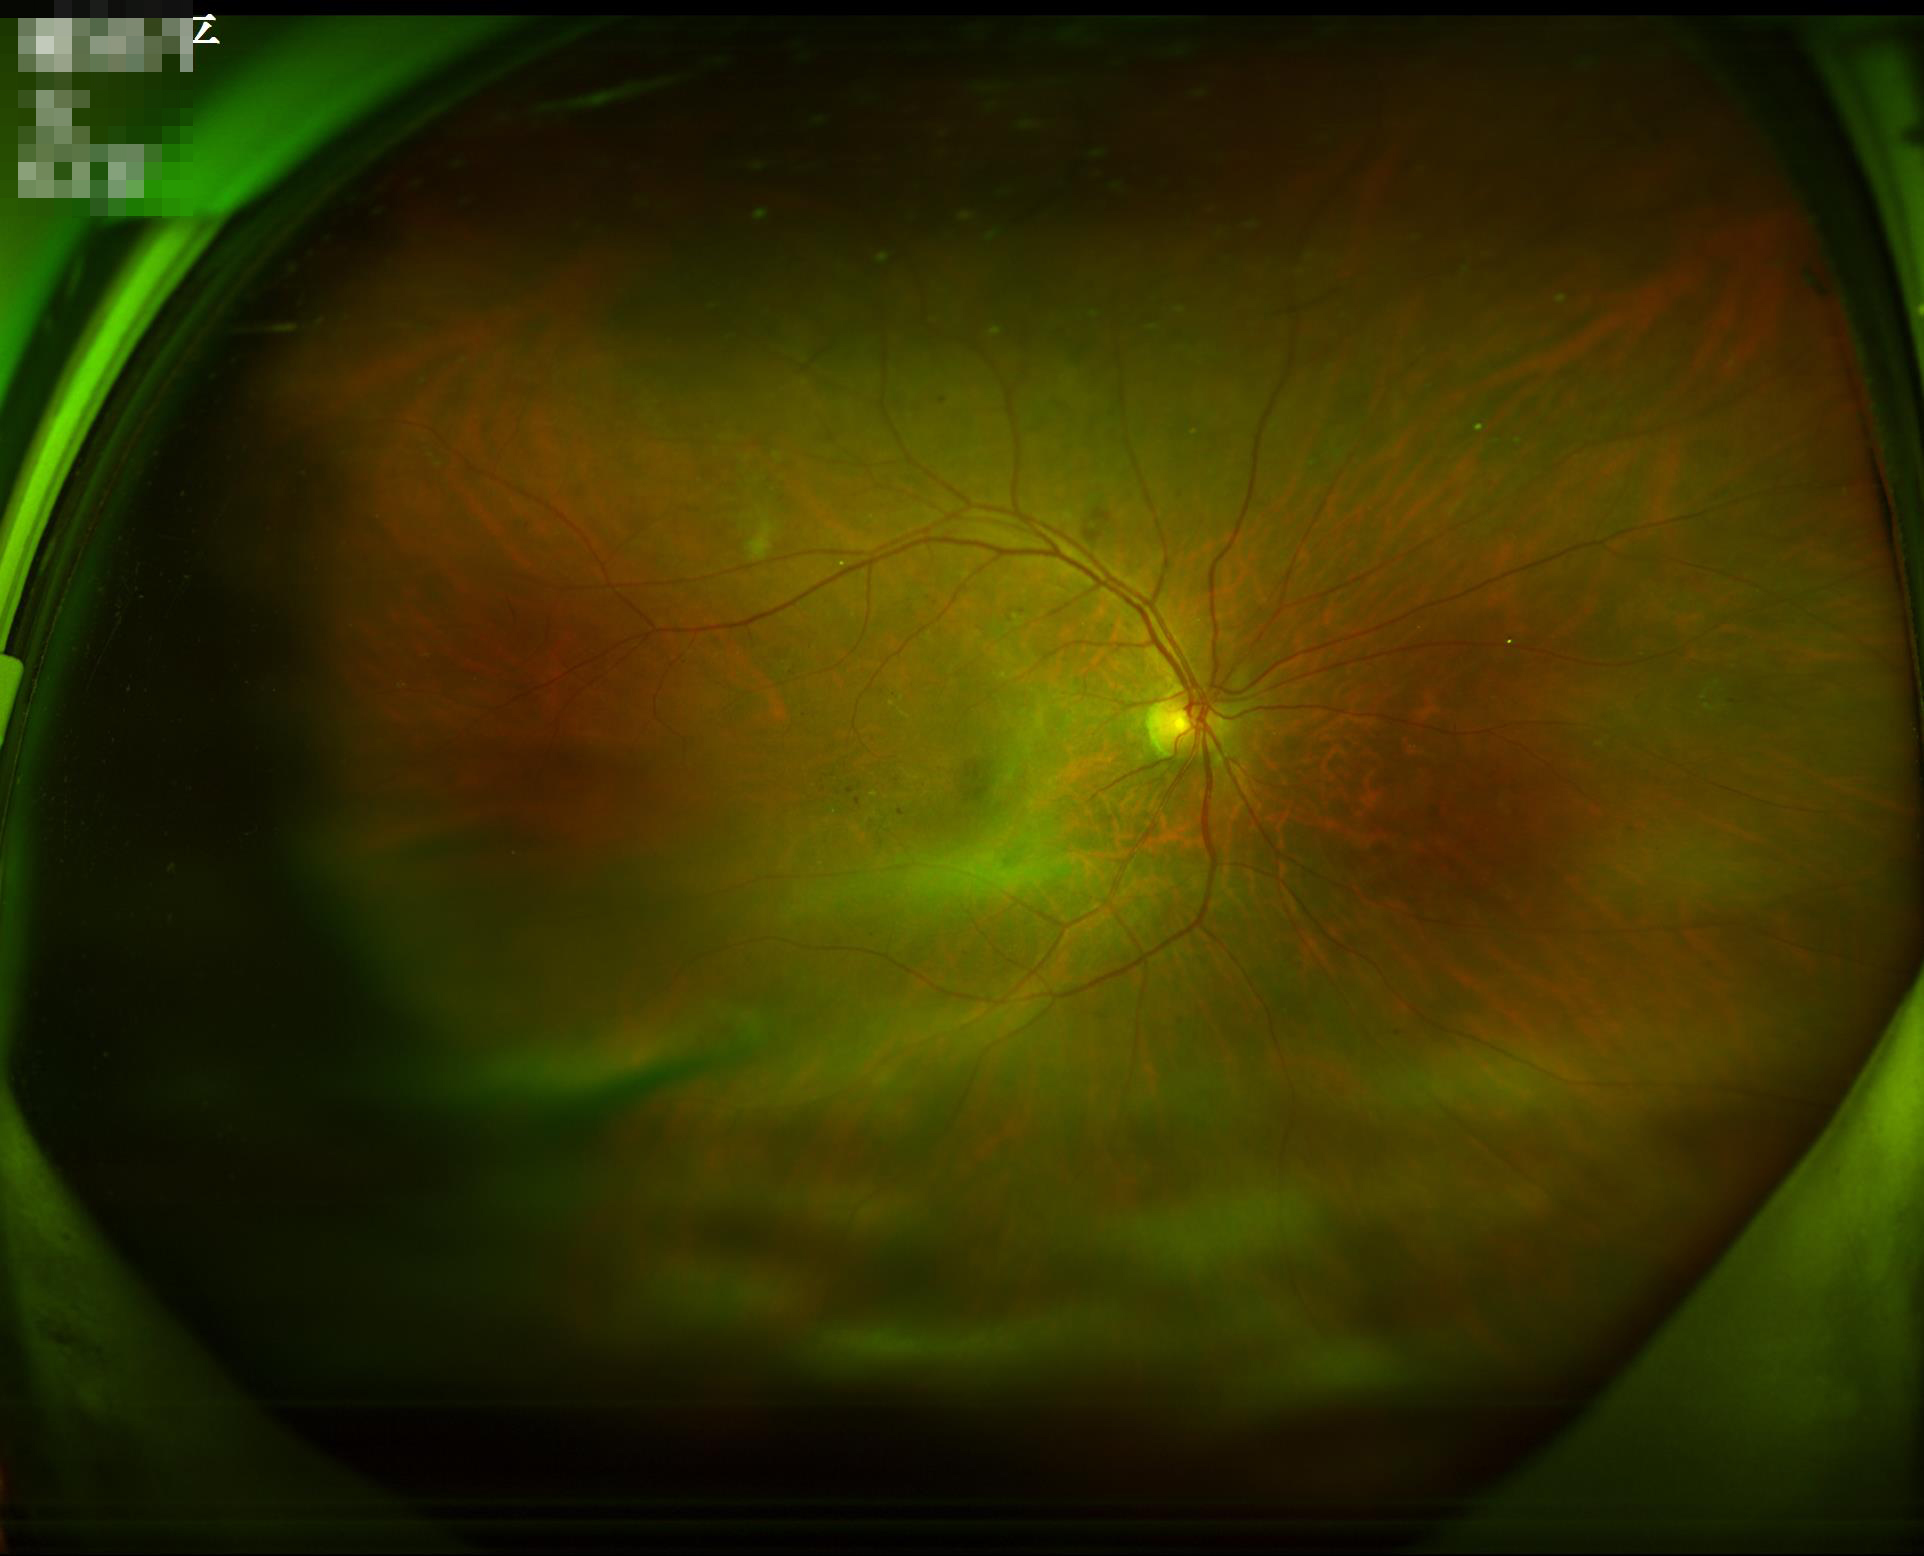 Contrast = good | Illumination = good | Focus = out of focus | Overall quality = good.